Color fundus image; 45-degree field of view; 2048 x 1536 pixels.
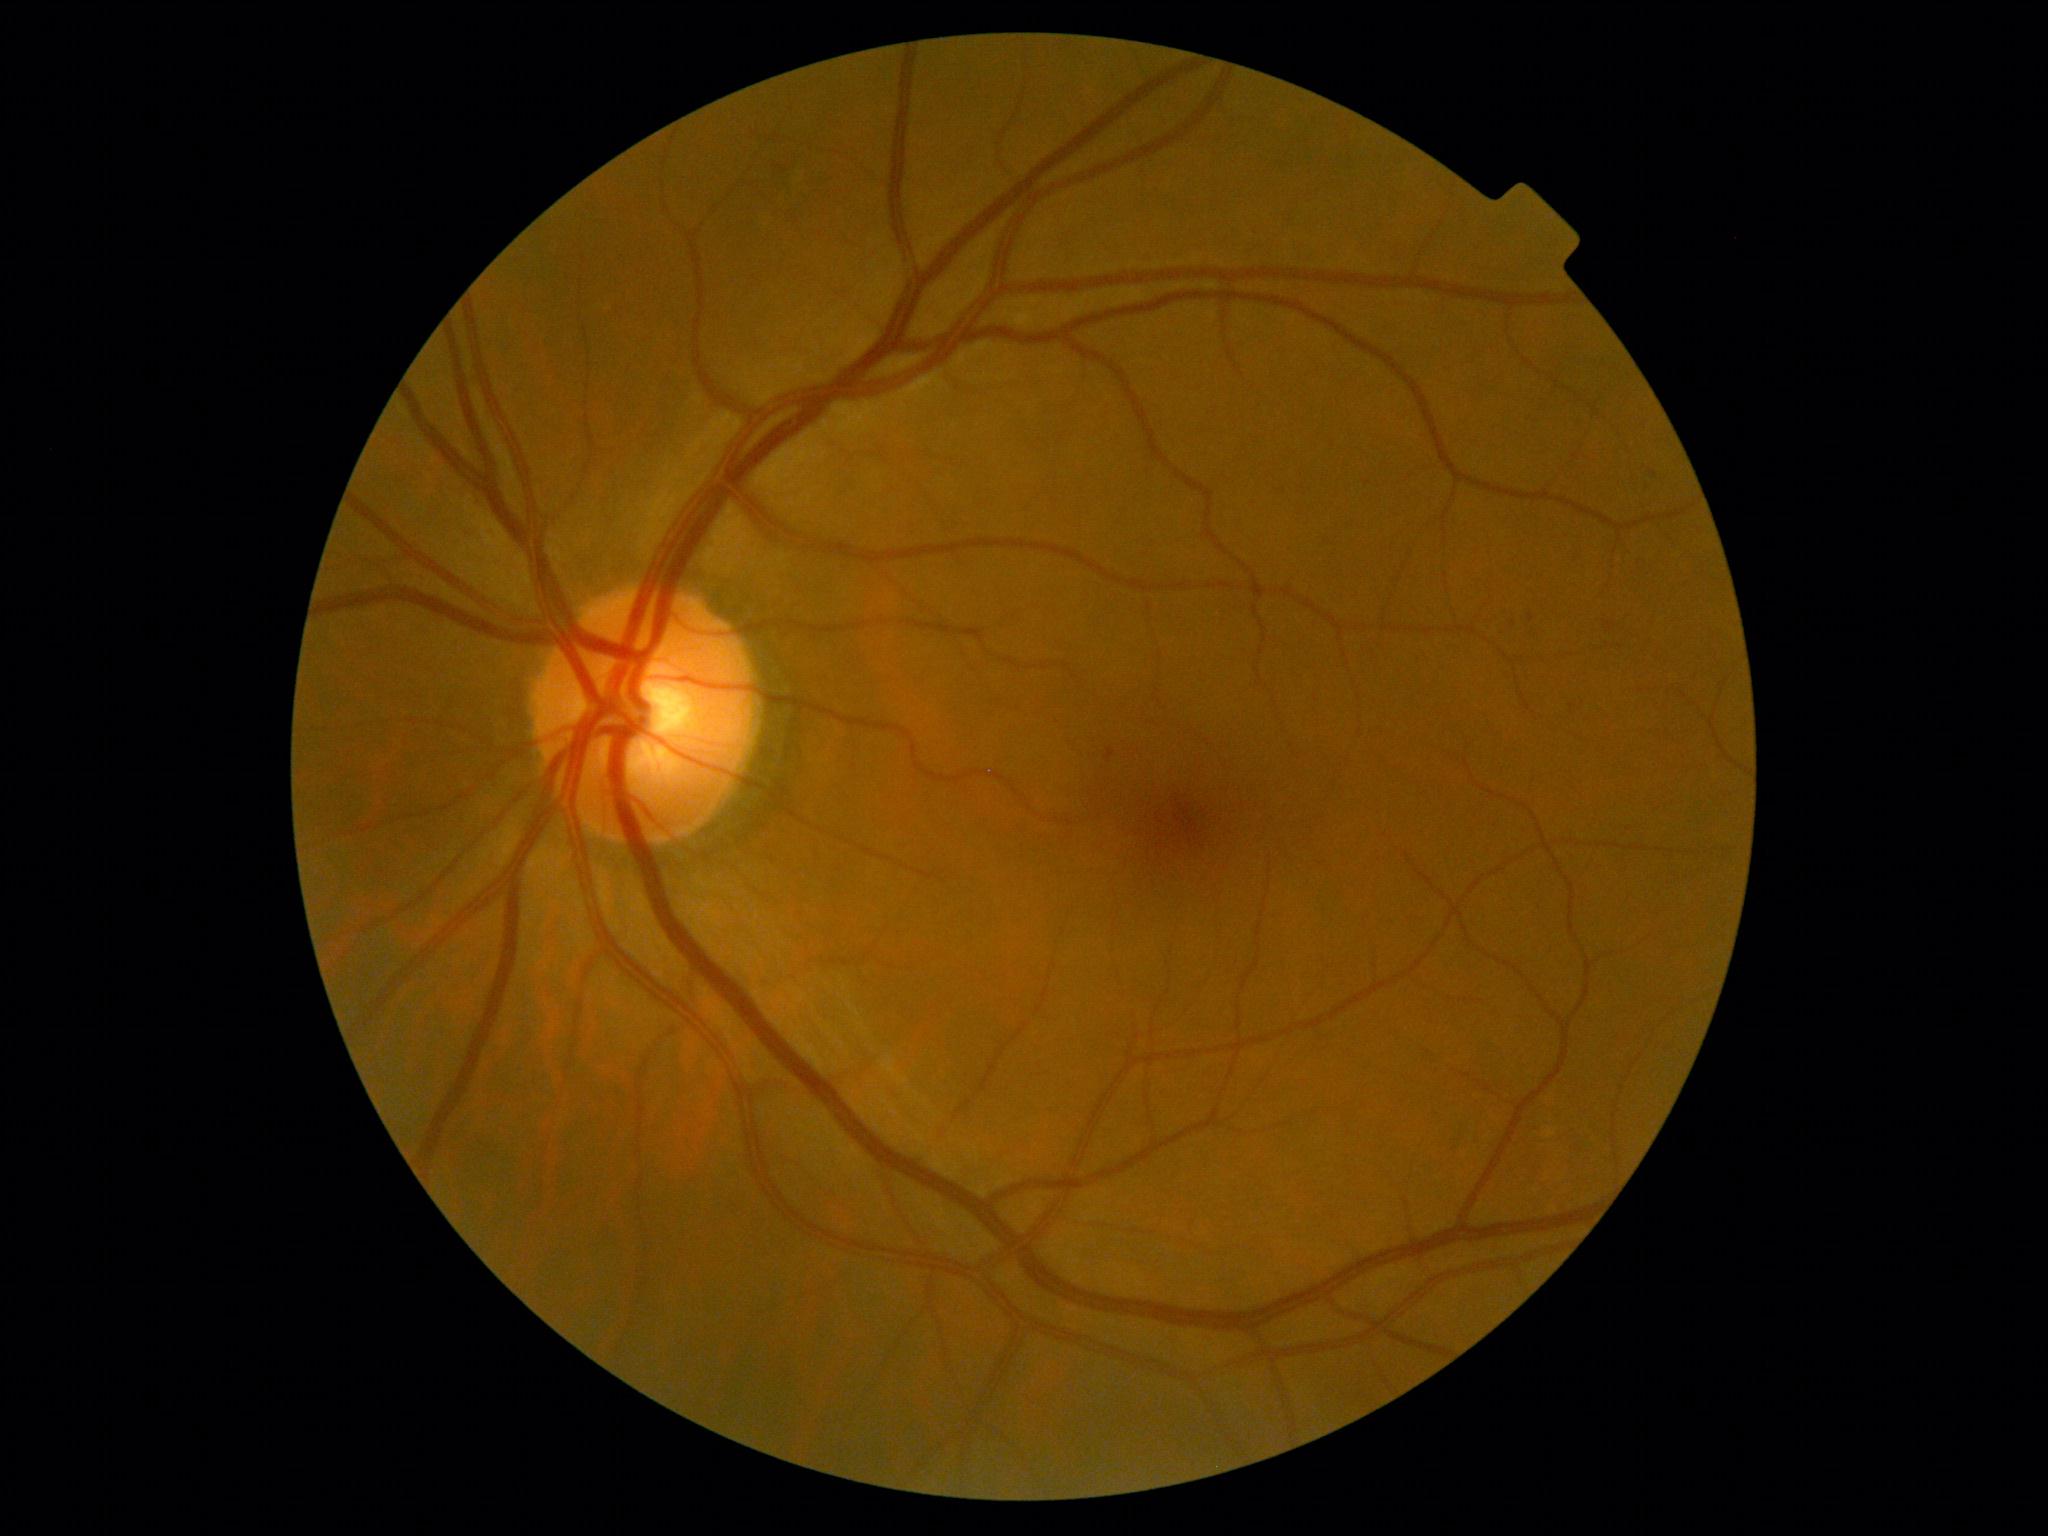

DR severity: 1/4.